Acquired with a NIDEK AFC-230; Davis DR grading; nonmydriatic:
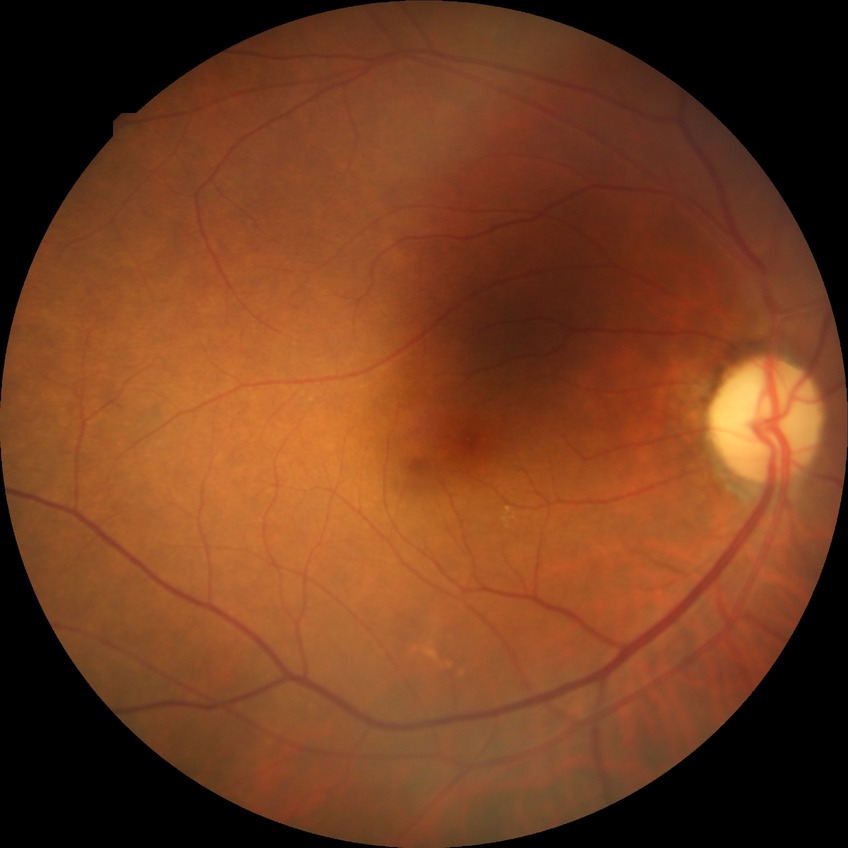 Davis grading: no diabetic retinopathy.